45-degree field of view: 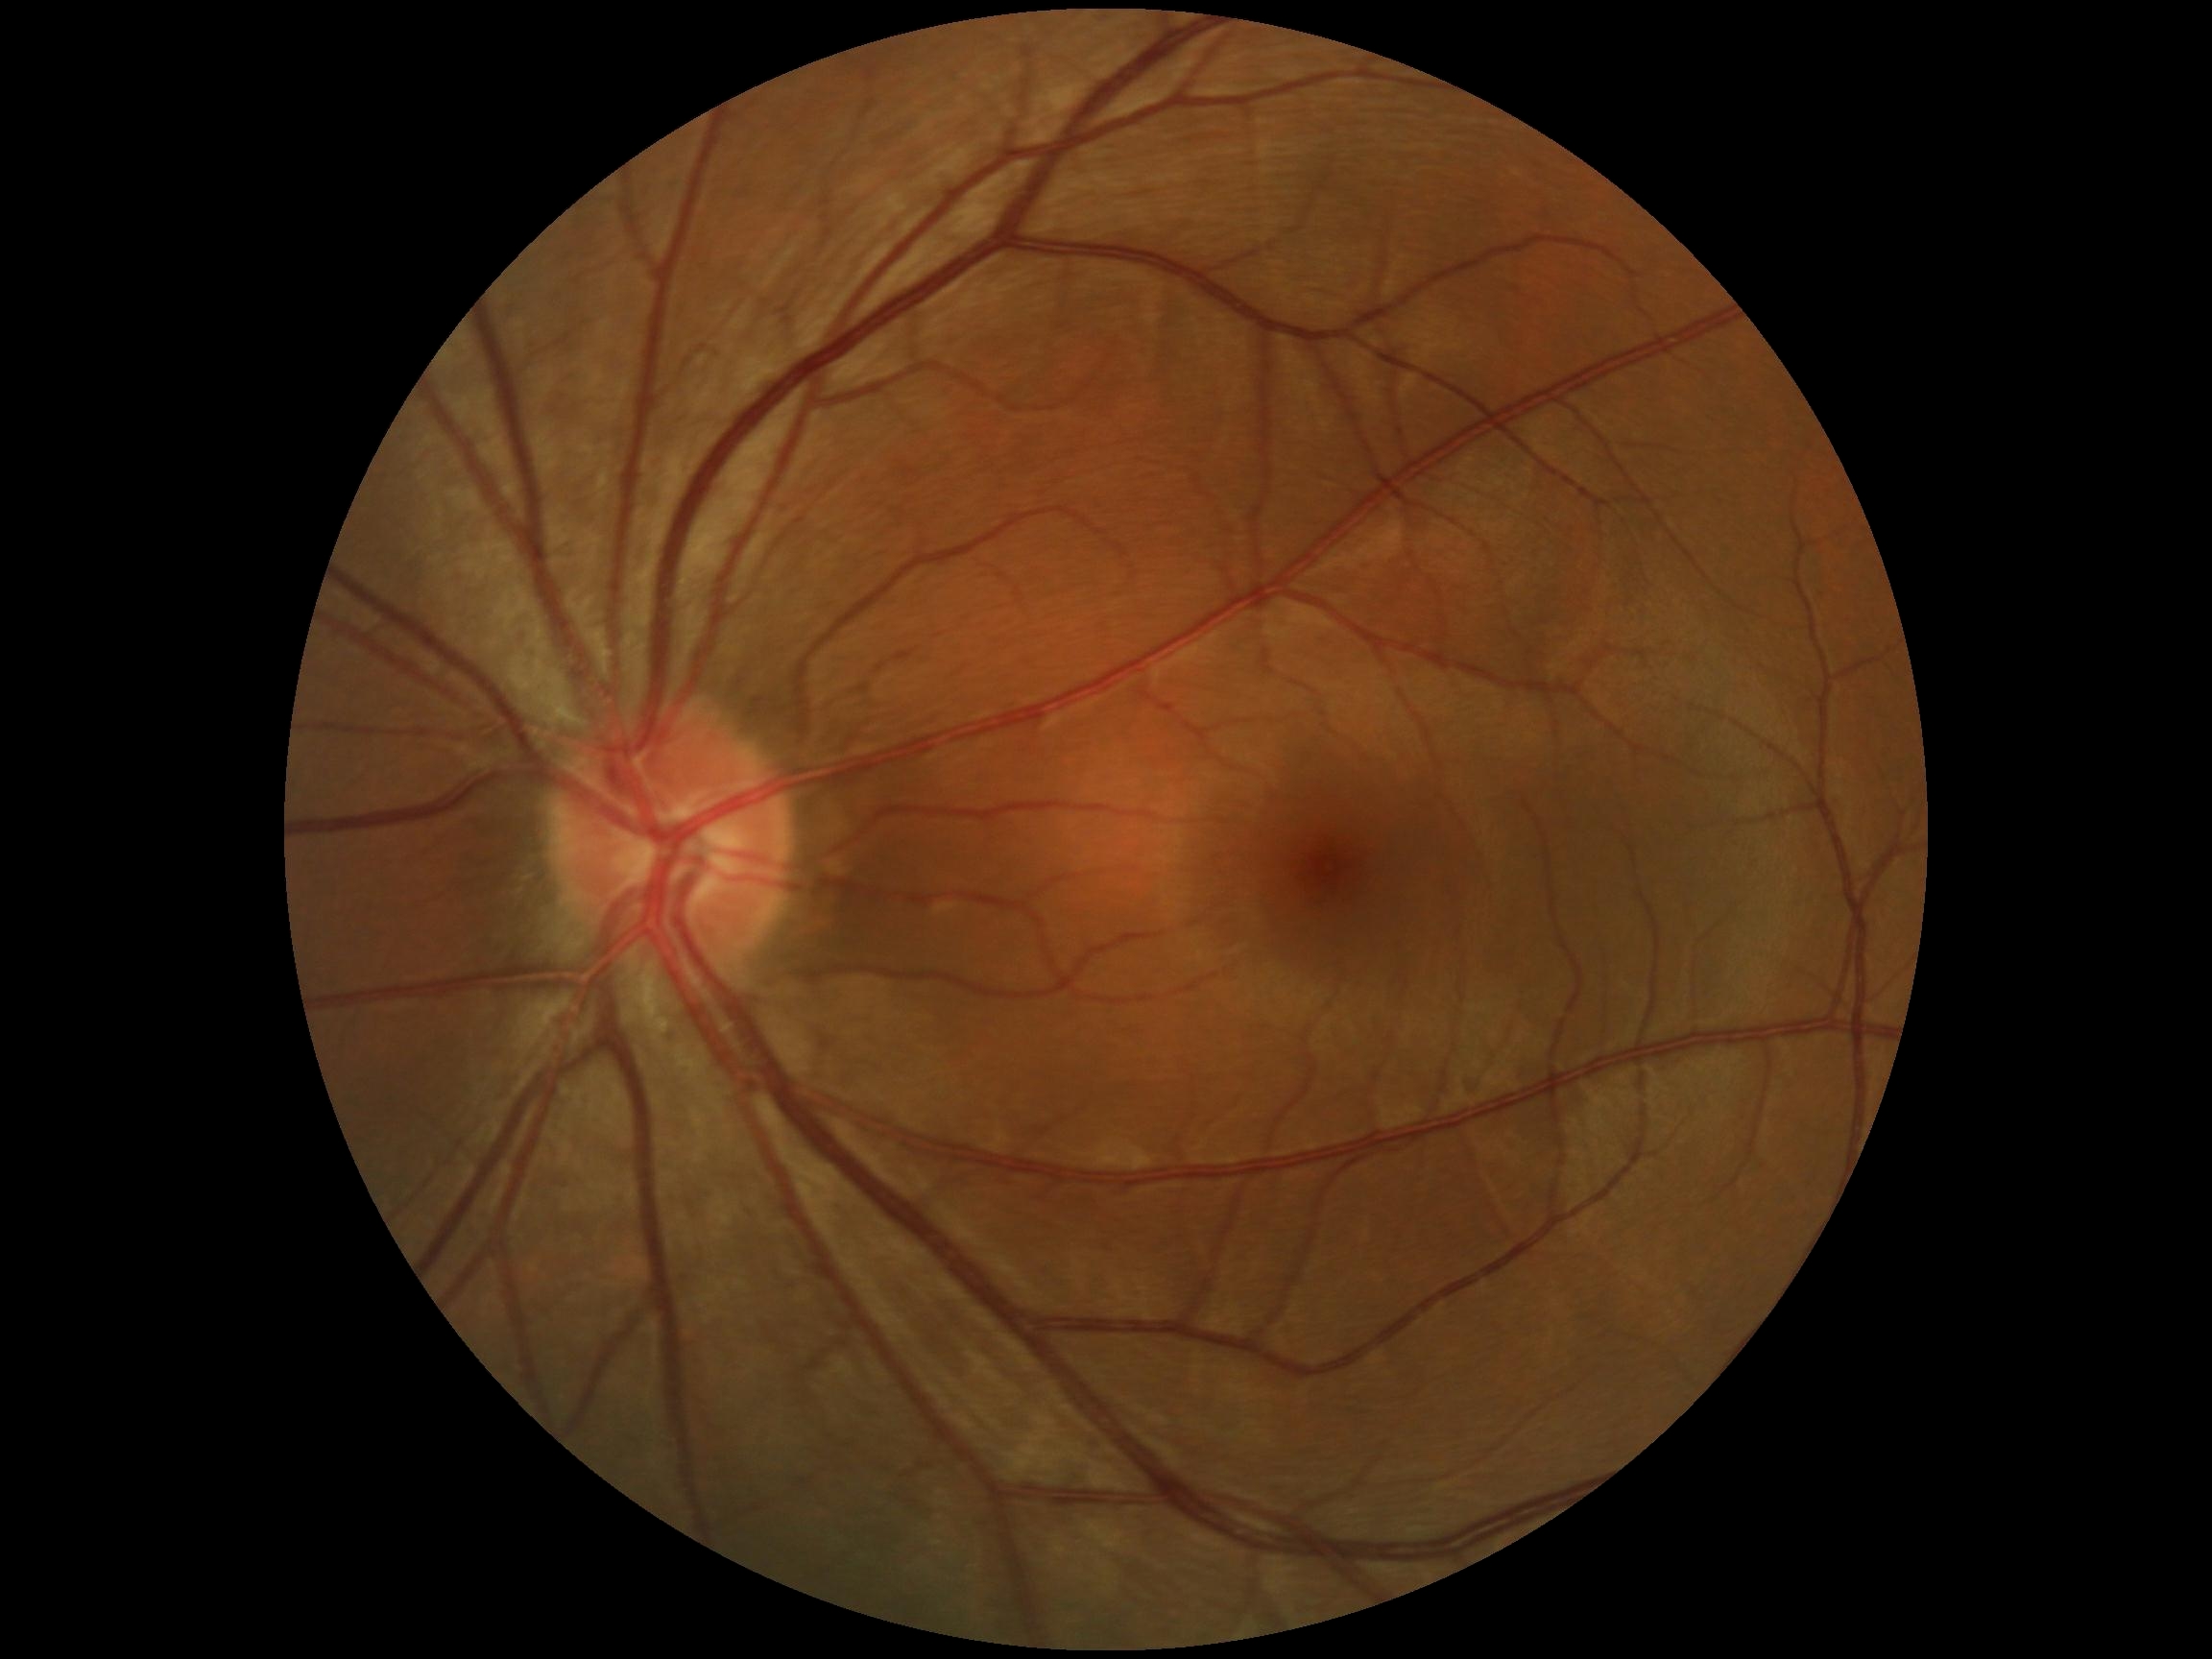

diabetic retinopathy (DR): 0 — no visible signs of diabetic retinopathy | DR impression: no apparent DR.